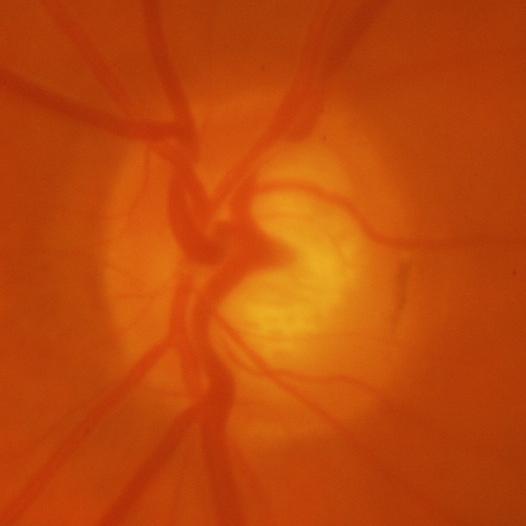

Glaucoma is present. There is evidence of glaucomatous findings.